CFP; image size 2352x1568 — 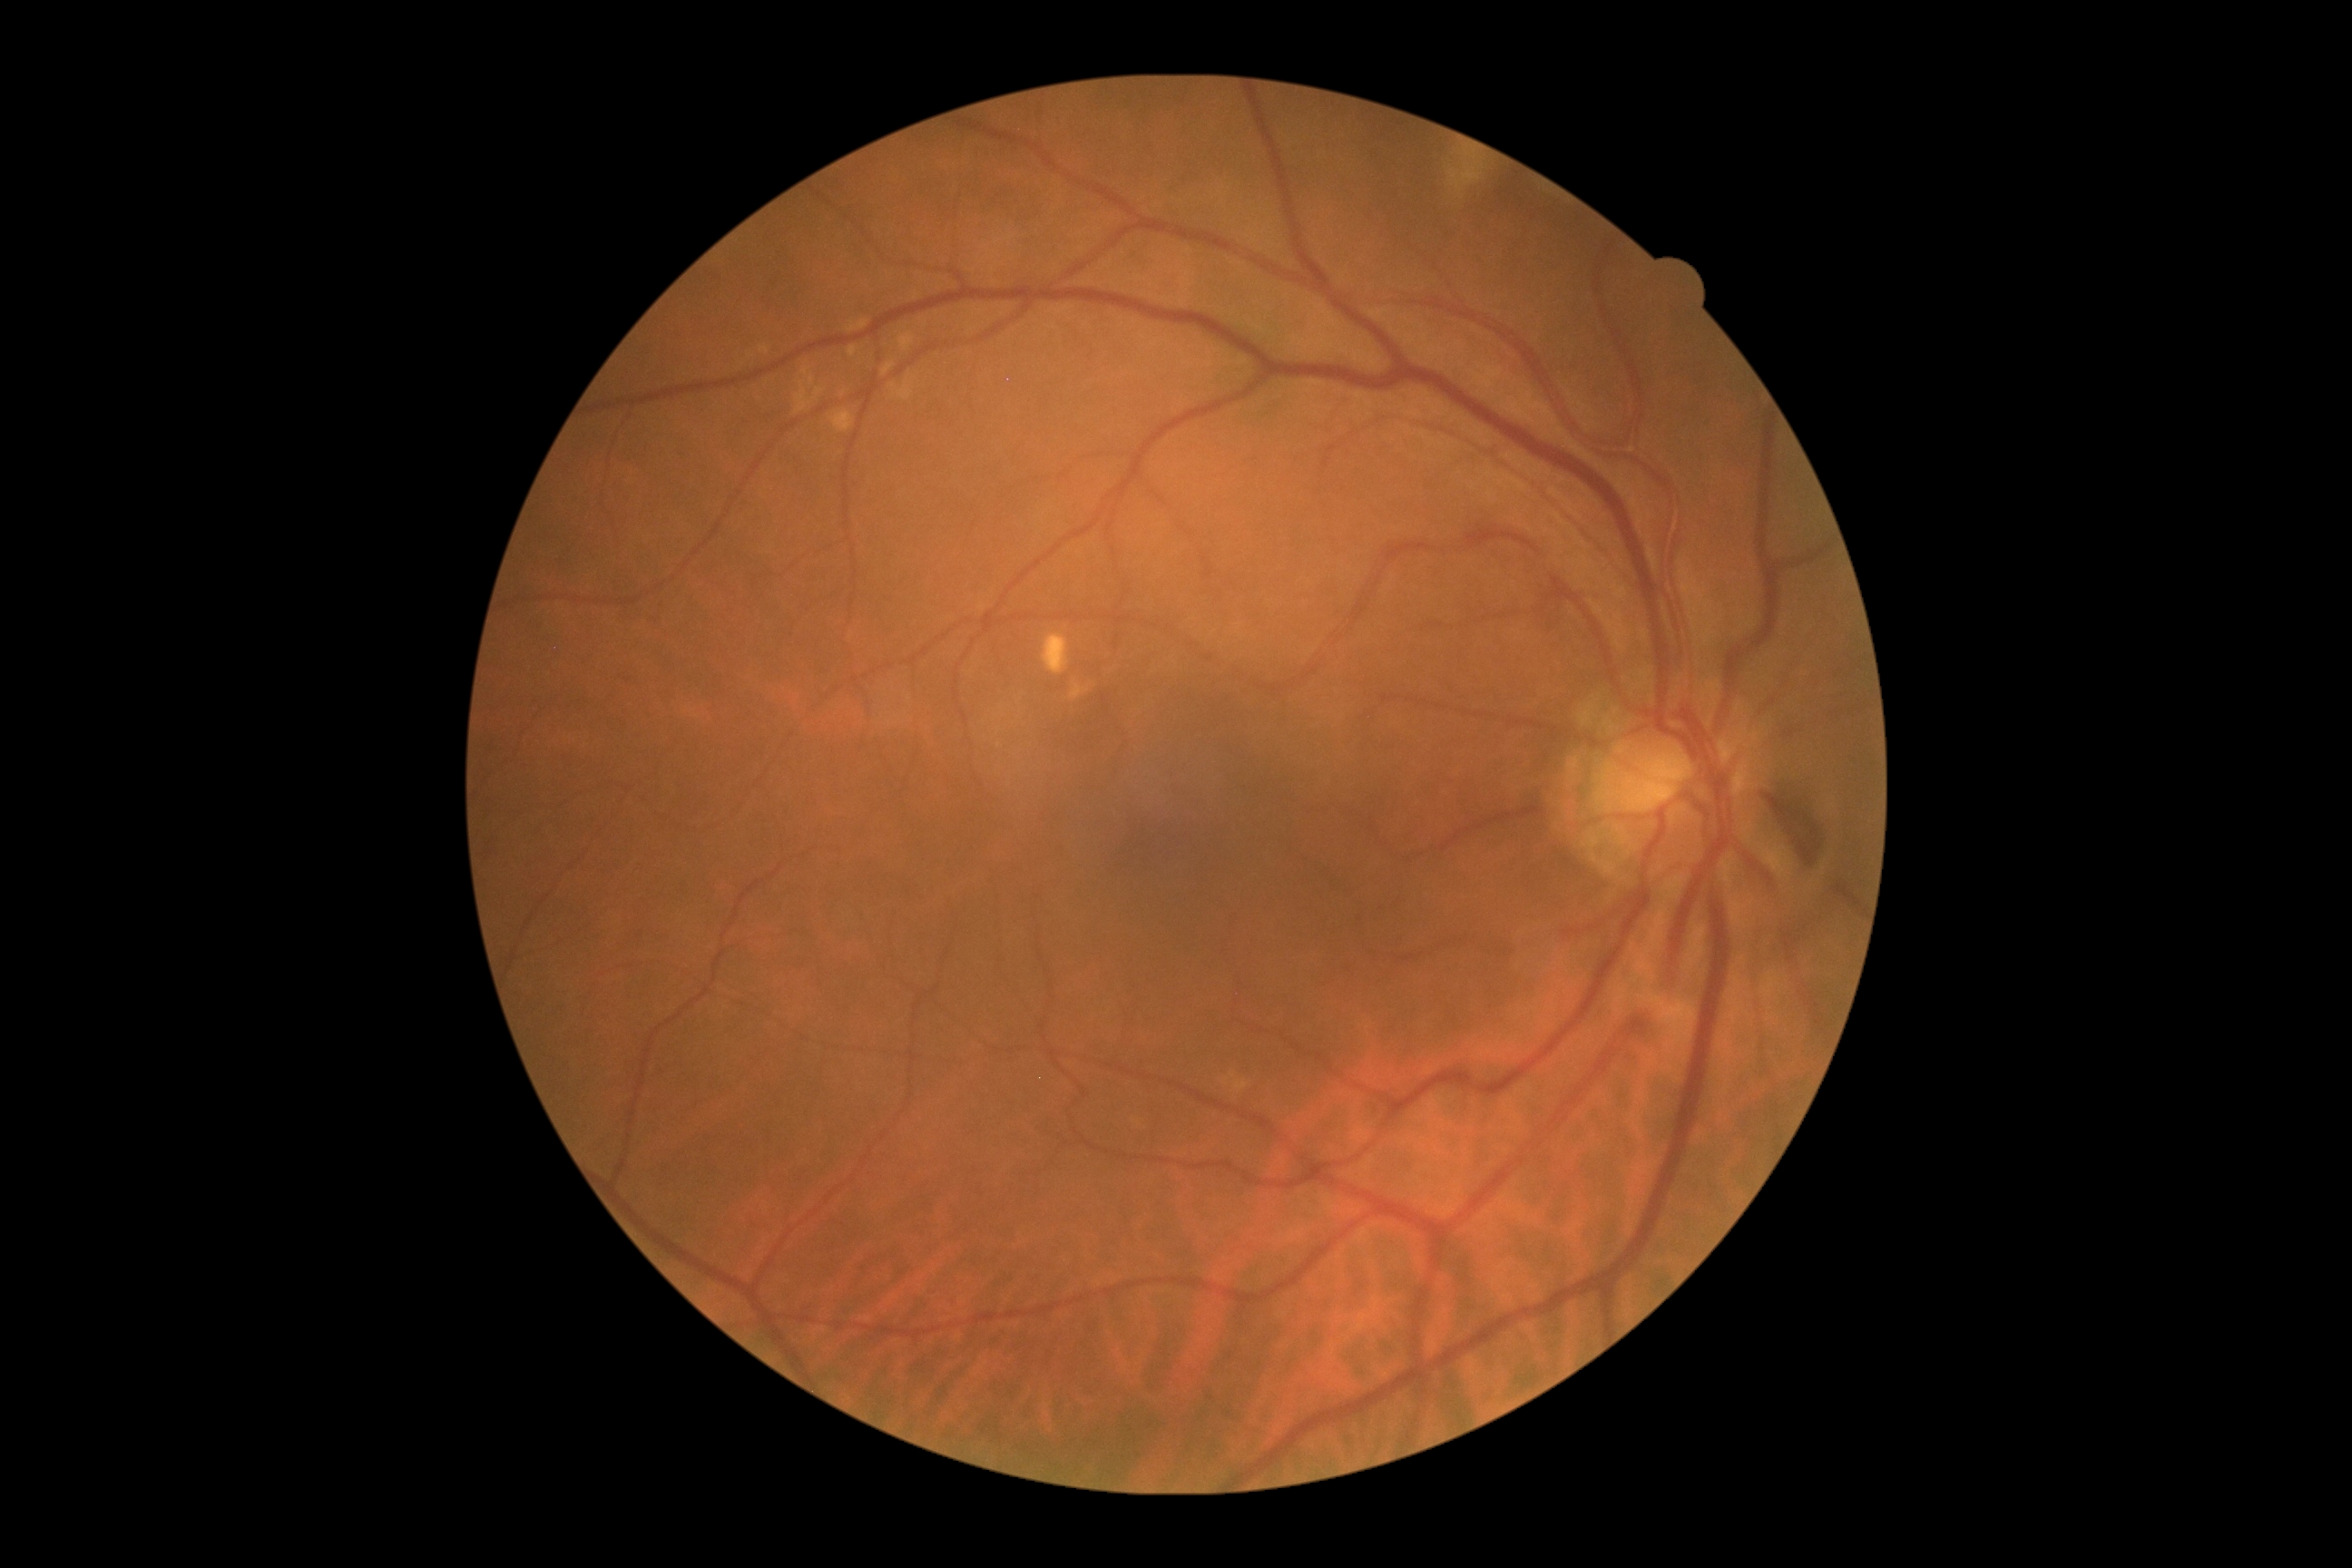 • DR stage — 0/4 — no visible signs of diabetic retinopathy